Acquired with a NIDEK AFC-230, Davis DR grading:
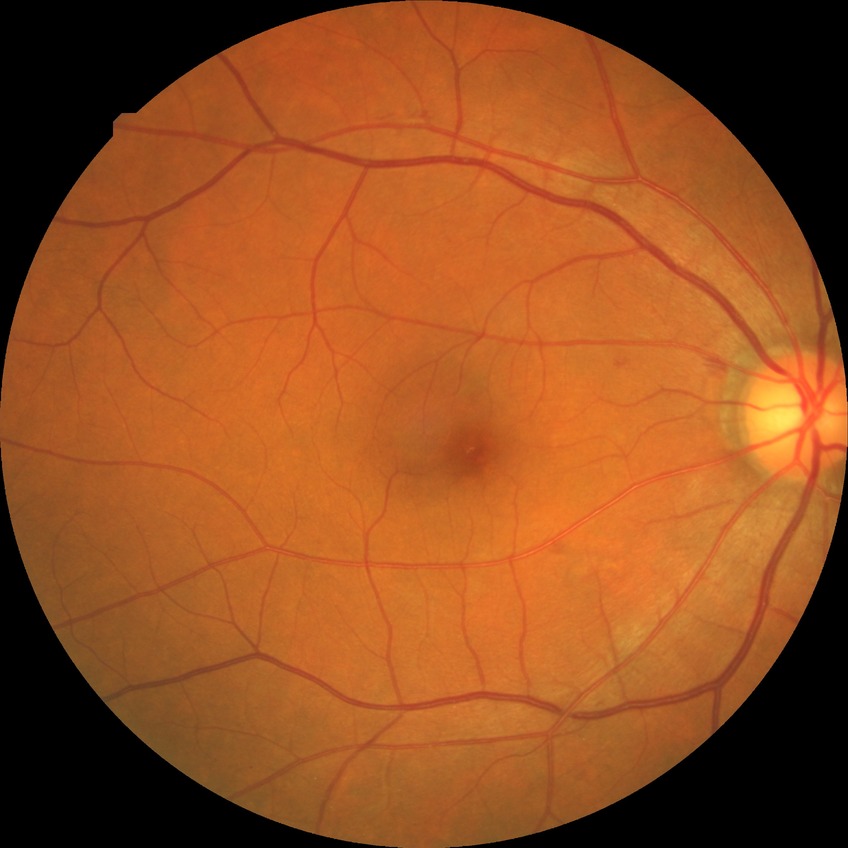
Diabetic retinopathy stage: simple diabetic retinopathy.